CFP.
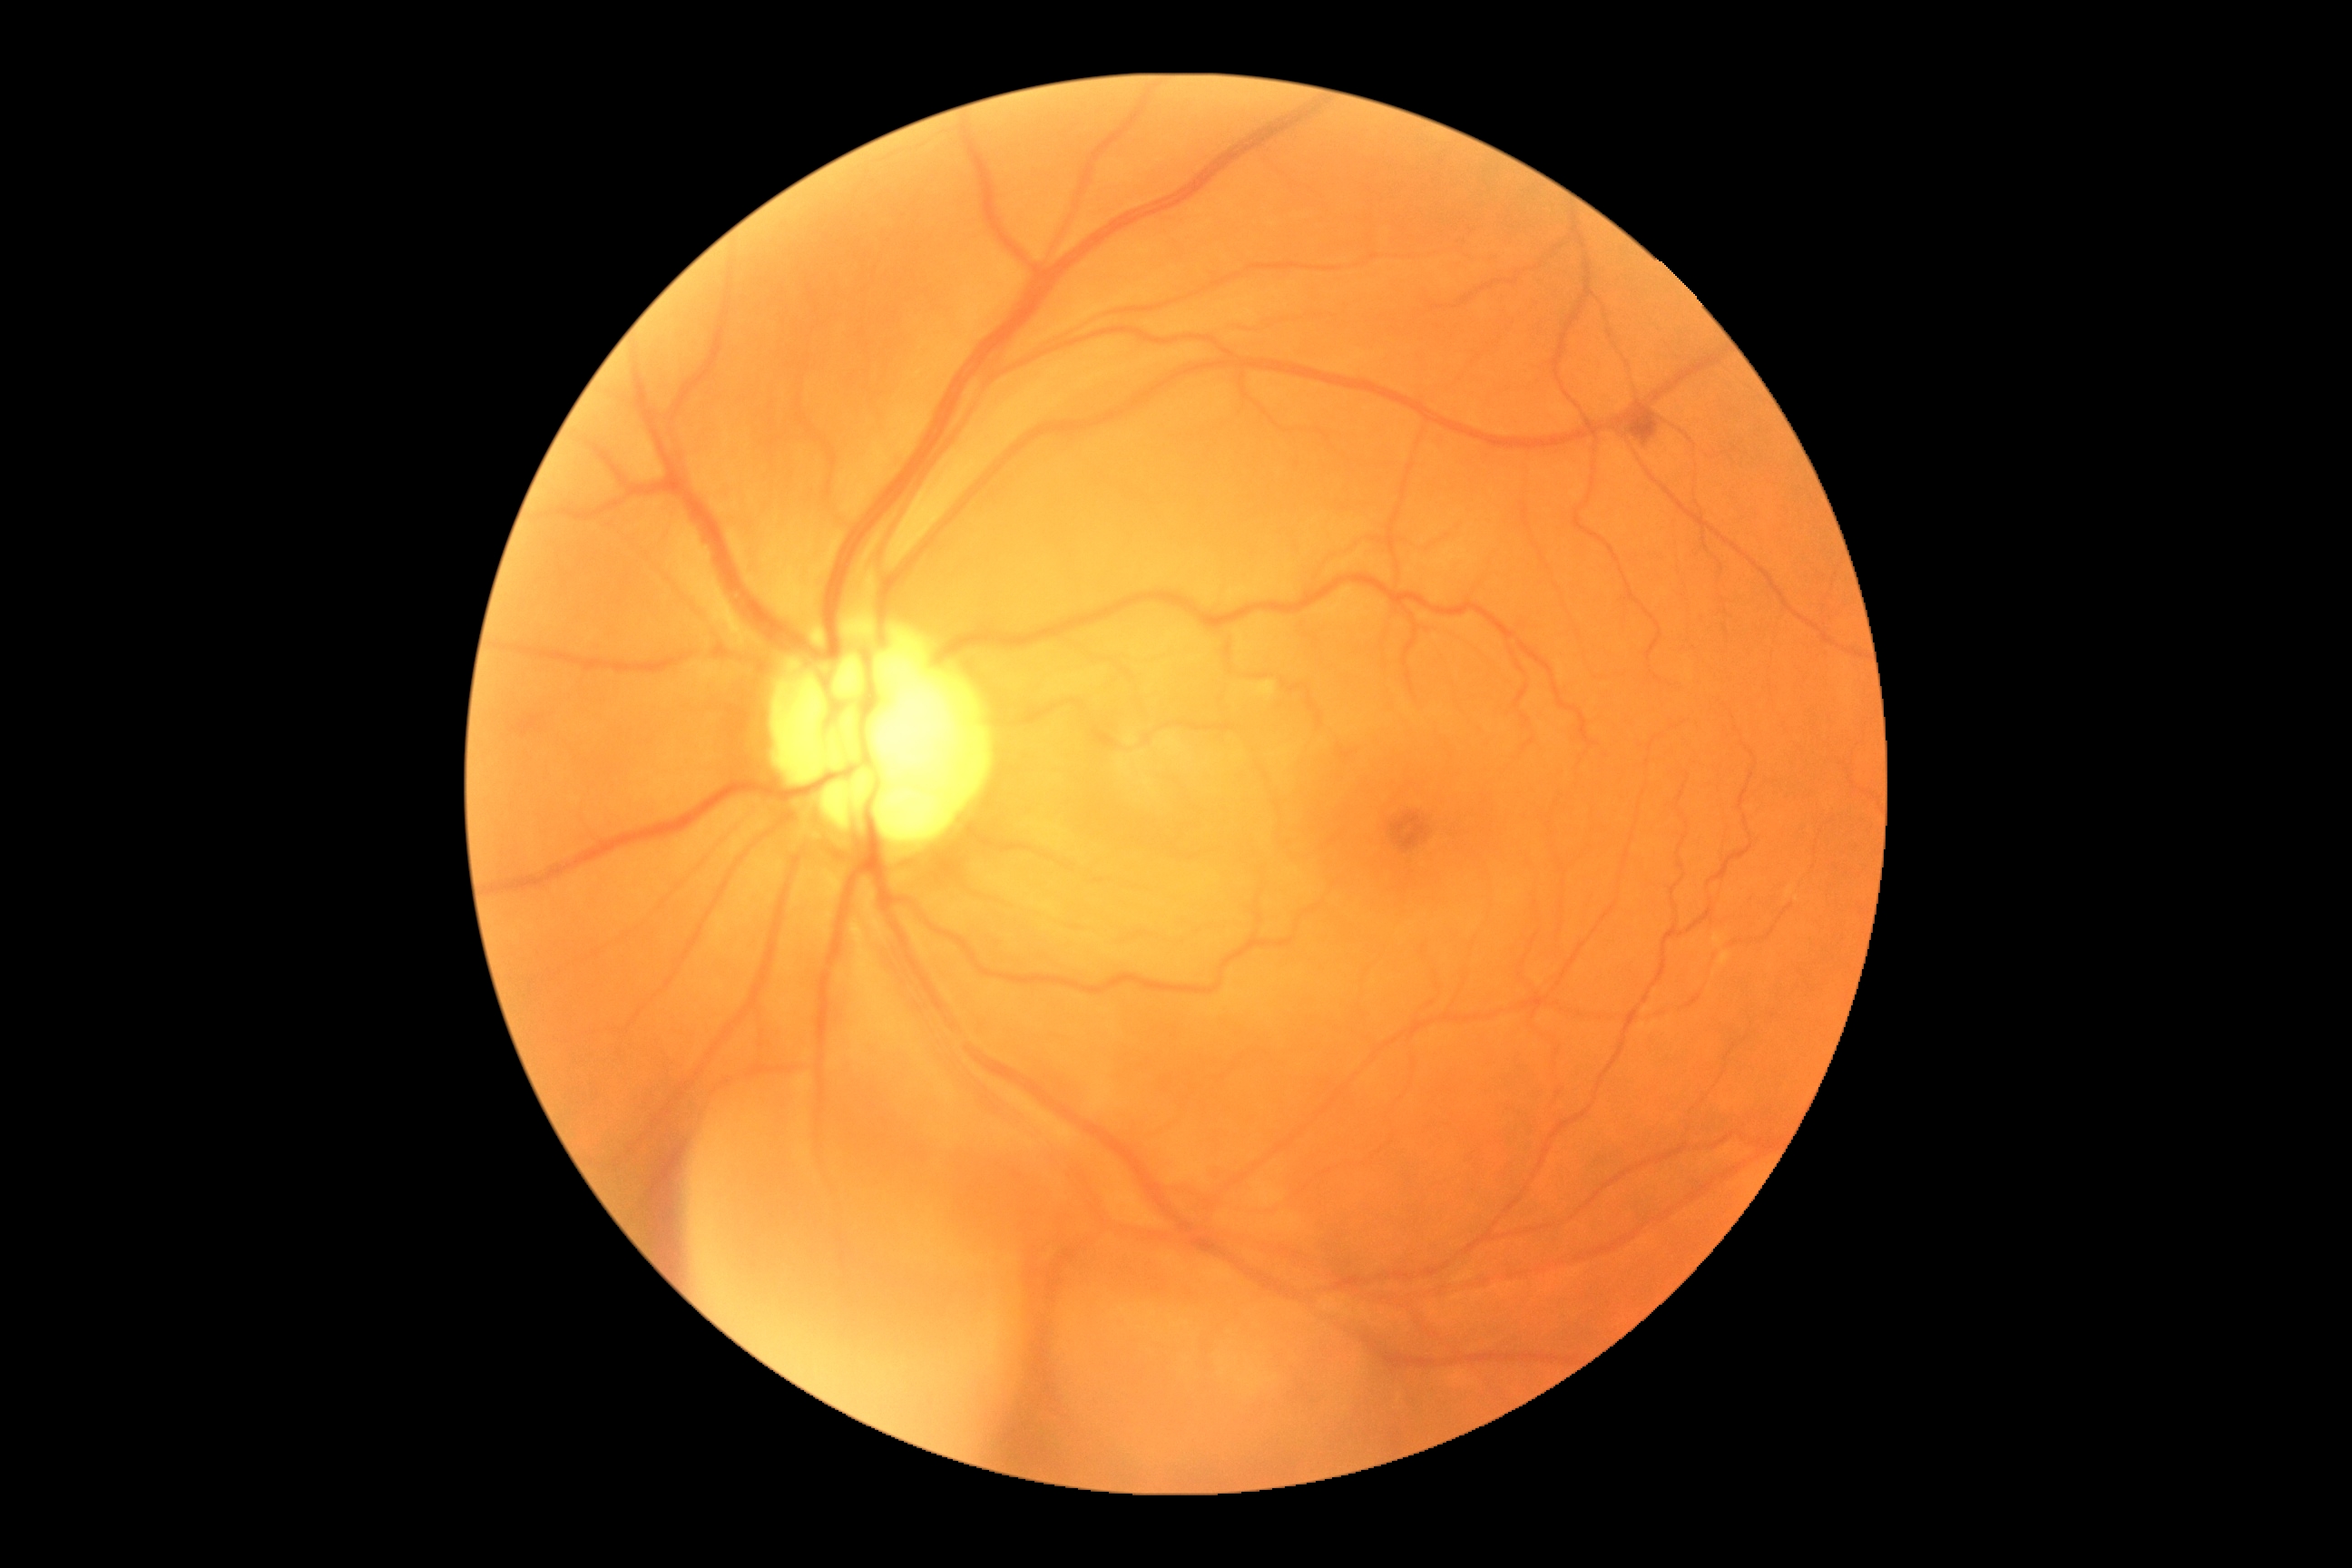 – diabetic retinopathy (DR): moderate NPDR (grade 2)